Nonmydriatic fundus photograph. 45-degree field of view. Posterior pole color fundus photograph. 848x848px. Acquired with a NIDEK AFC-230: 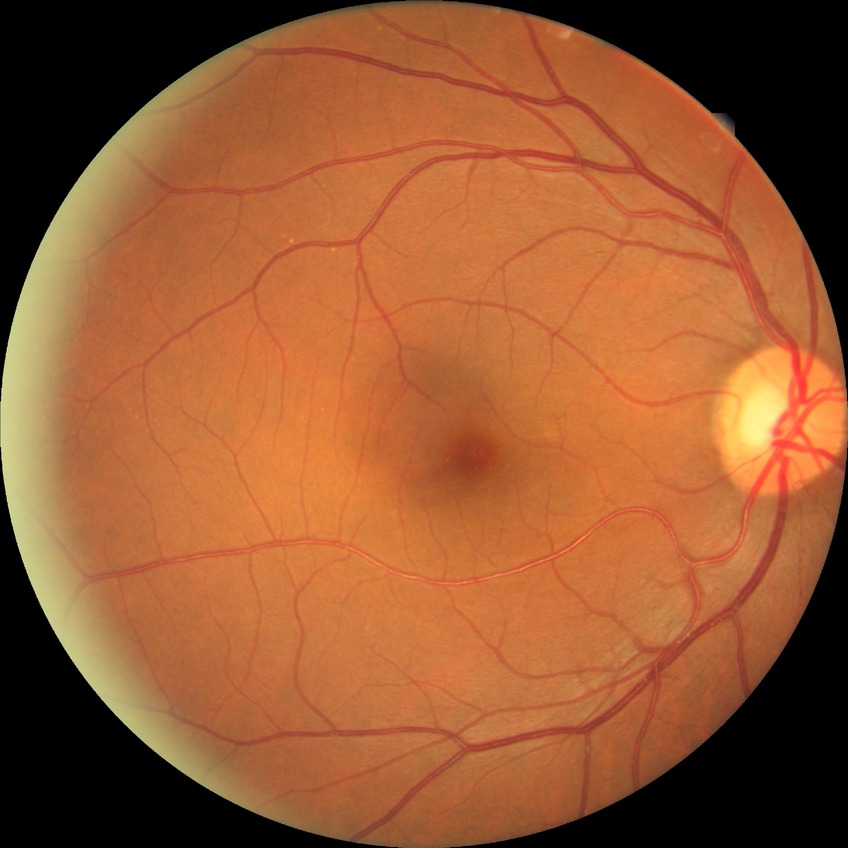 Diabetic retinopathy (DR) is NDR (no diabetic retinopathy).